45-degree field of view
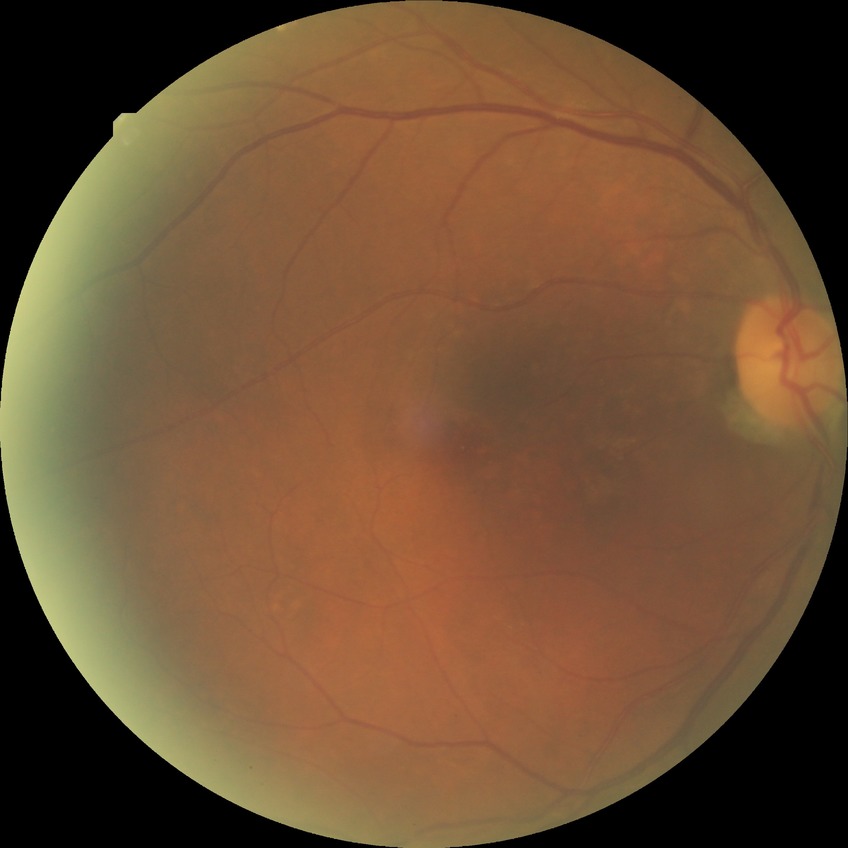

  davis_grade: NDR (no diabetic retinopathy)